Sex: M.
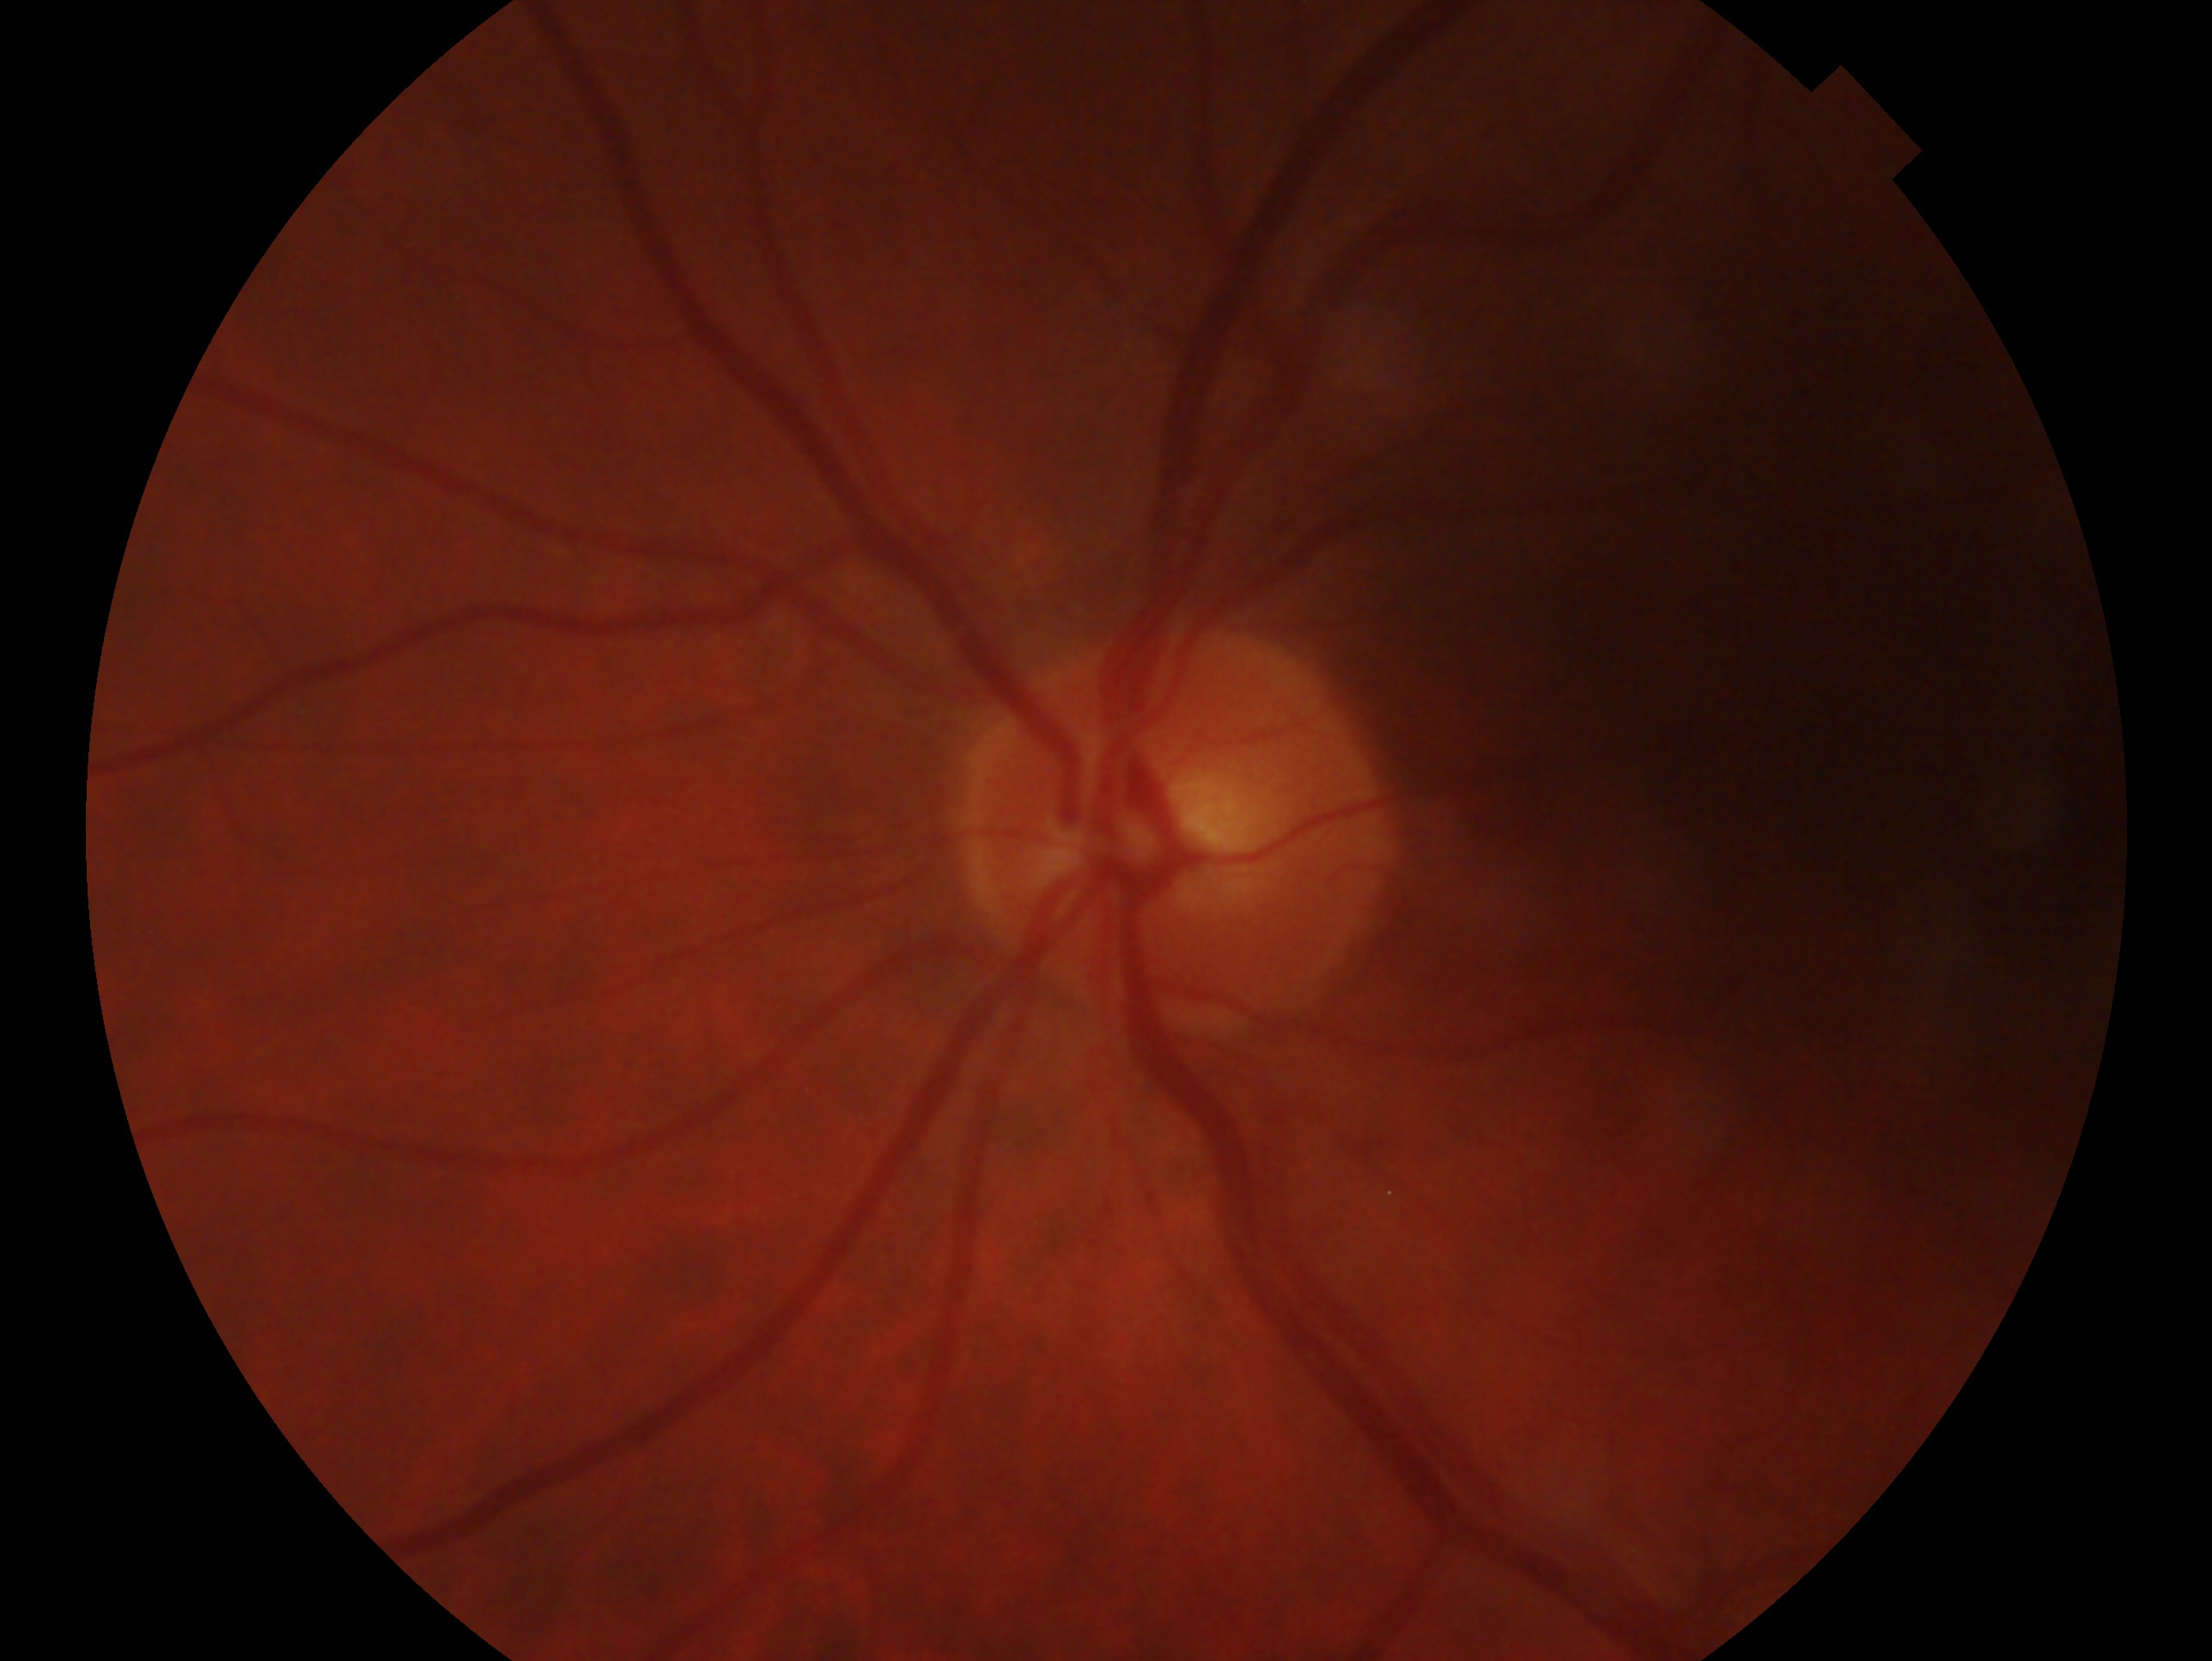 The image shows the left eye.
Impression: no evidence of glaucoma.